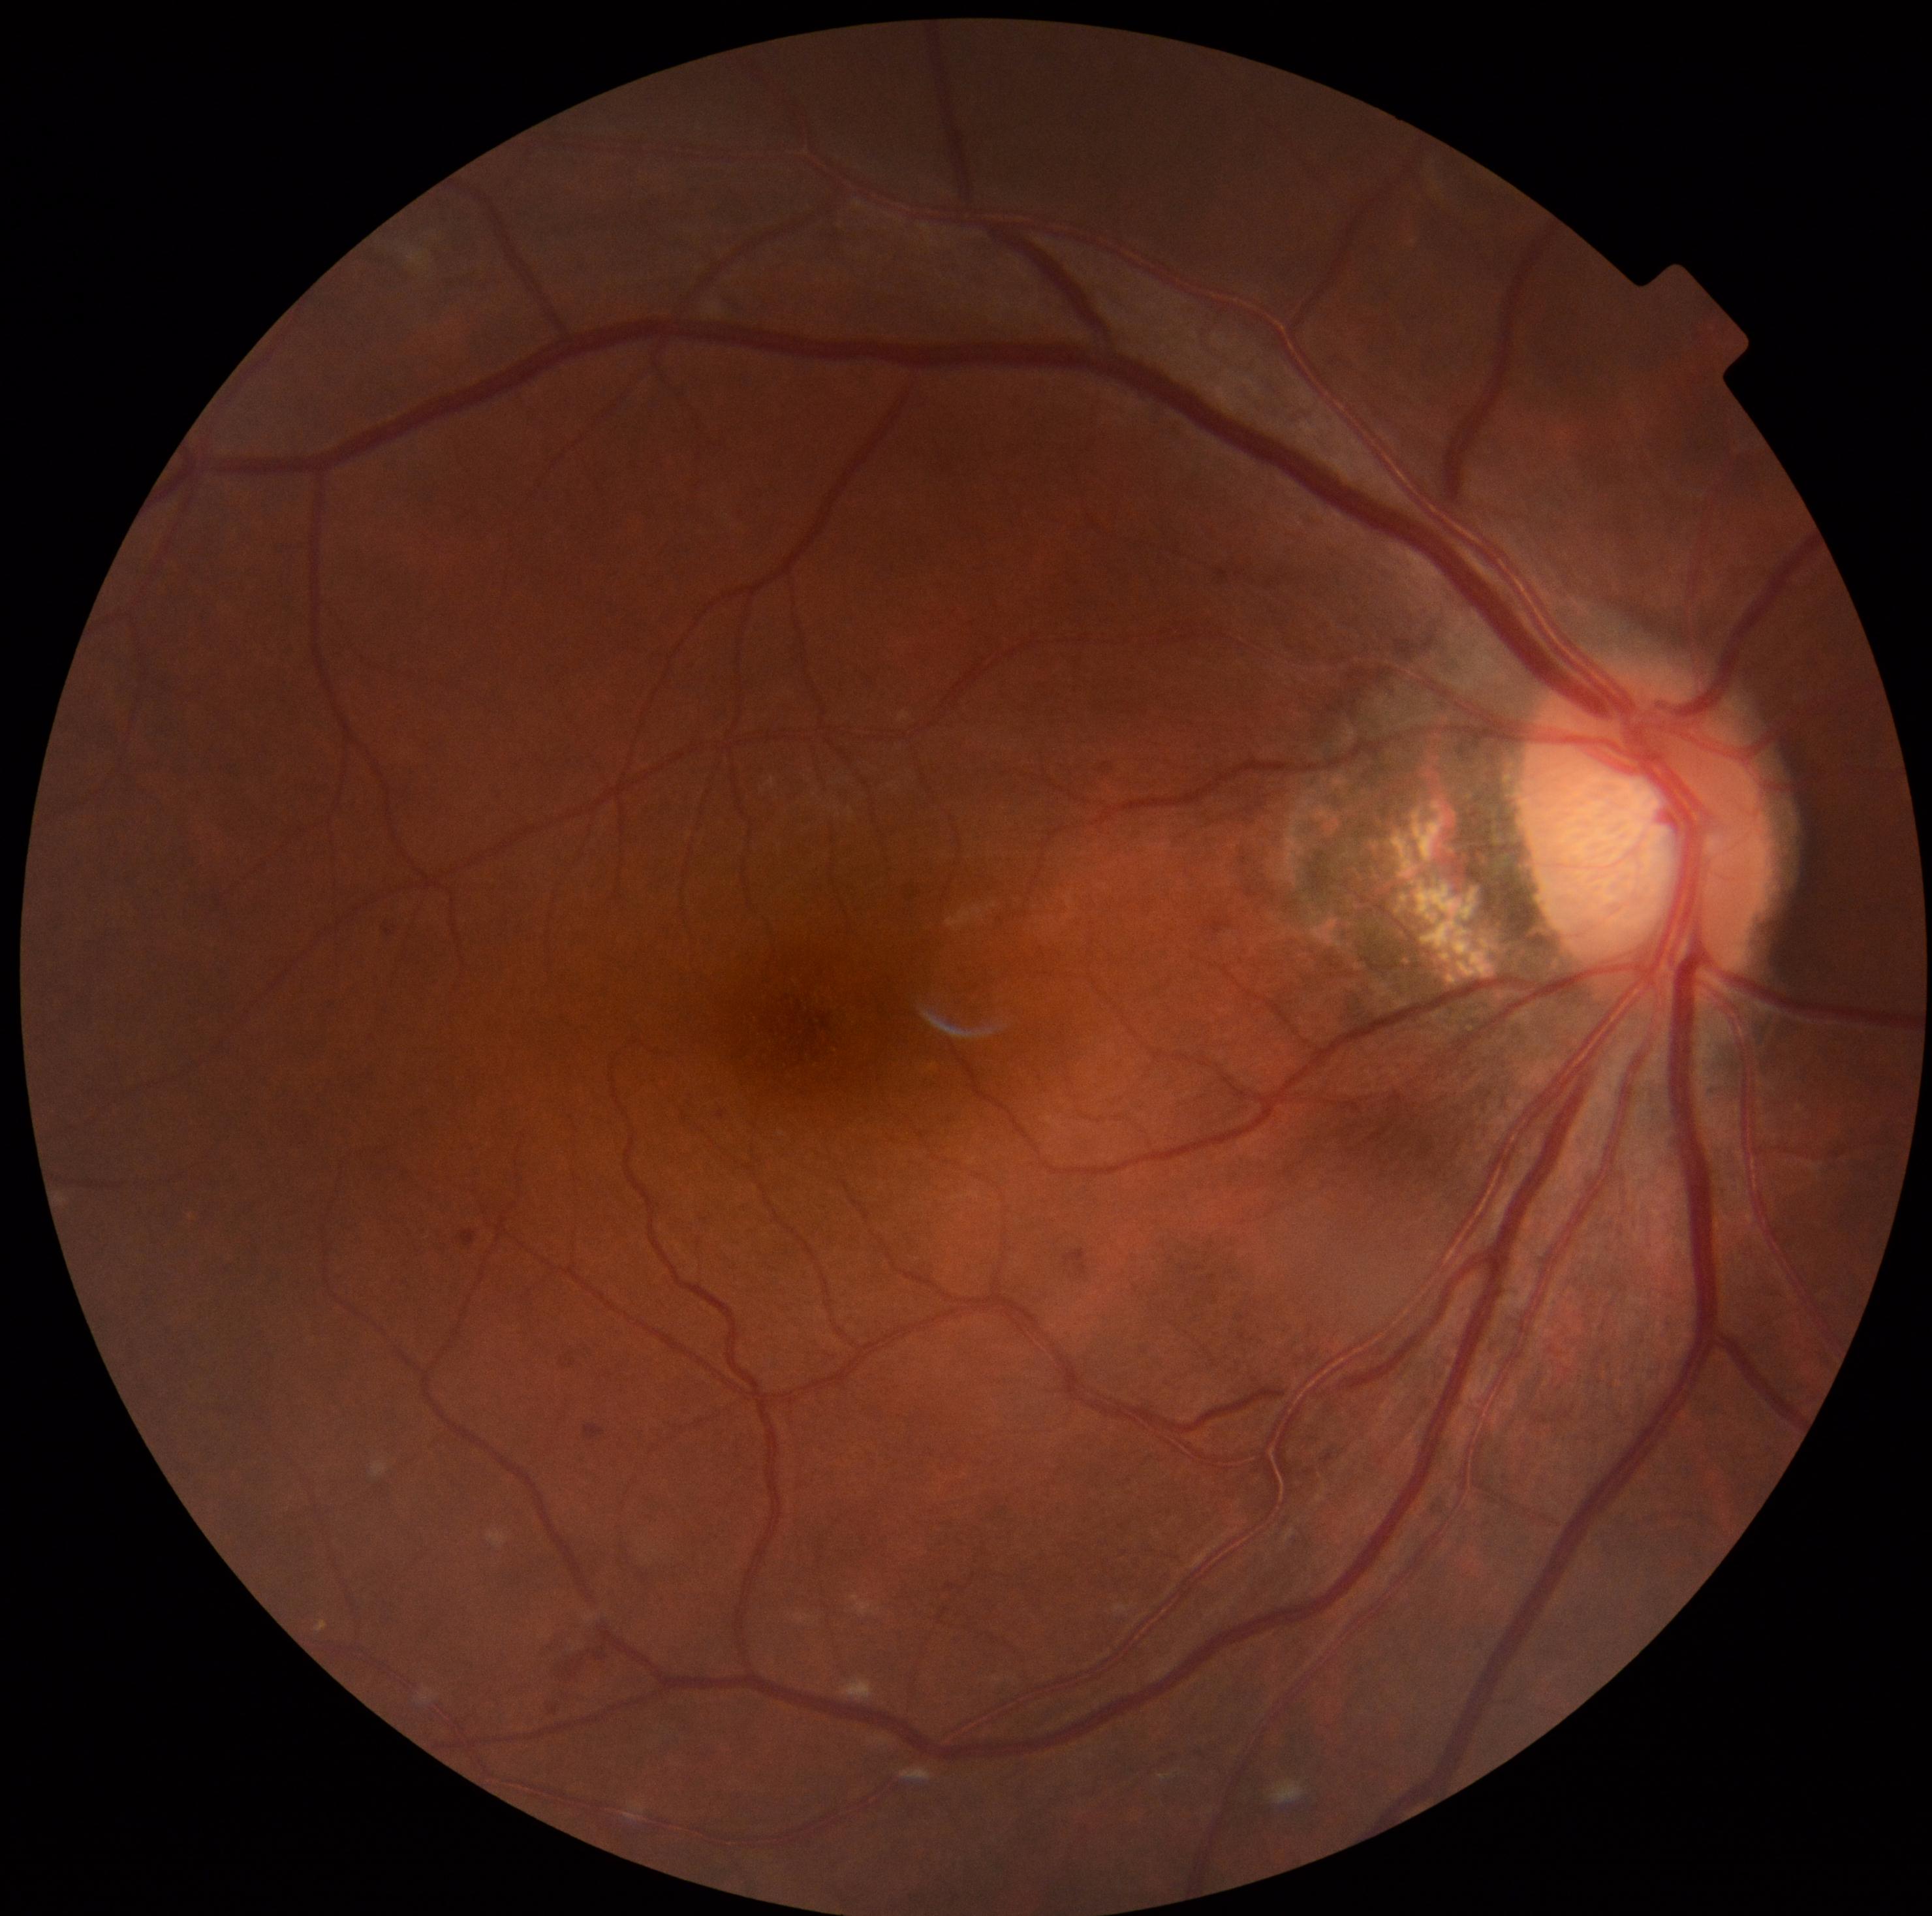
– diabetic retinopathy: moderate NPDR (grade 2) — more than just microaneurysms but less than severe NPDR